Captured with the Clarity RetCam 3 (130° field of view). 640 by 480 pixels. Pediatric retinal photograph (wide-field)
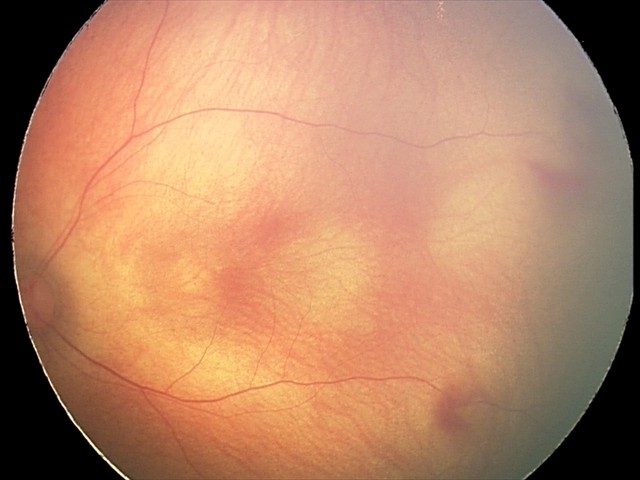
From an examination with diagnosis of retinal hemorrhages.